45° FOV · retinal fundus photograph:
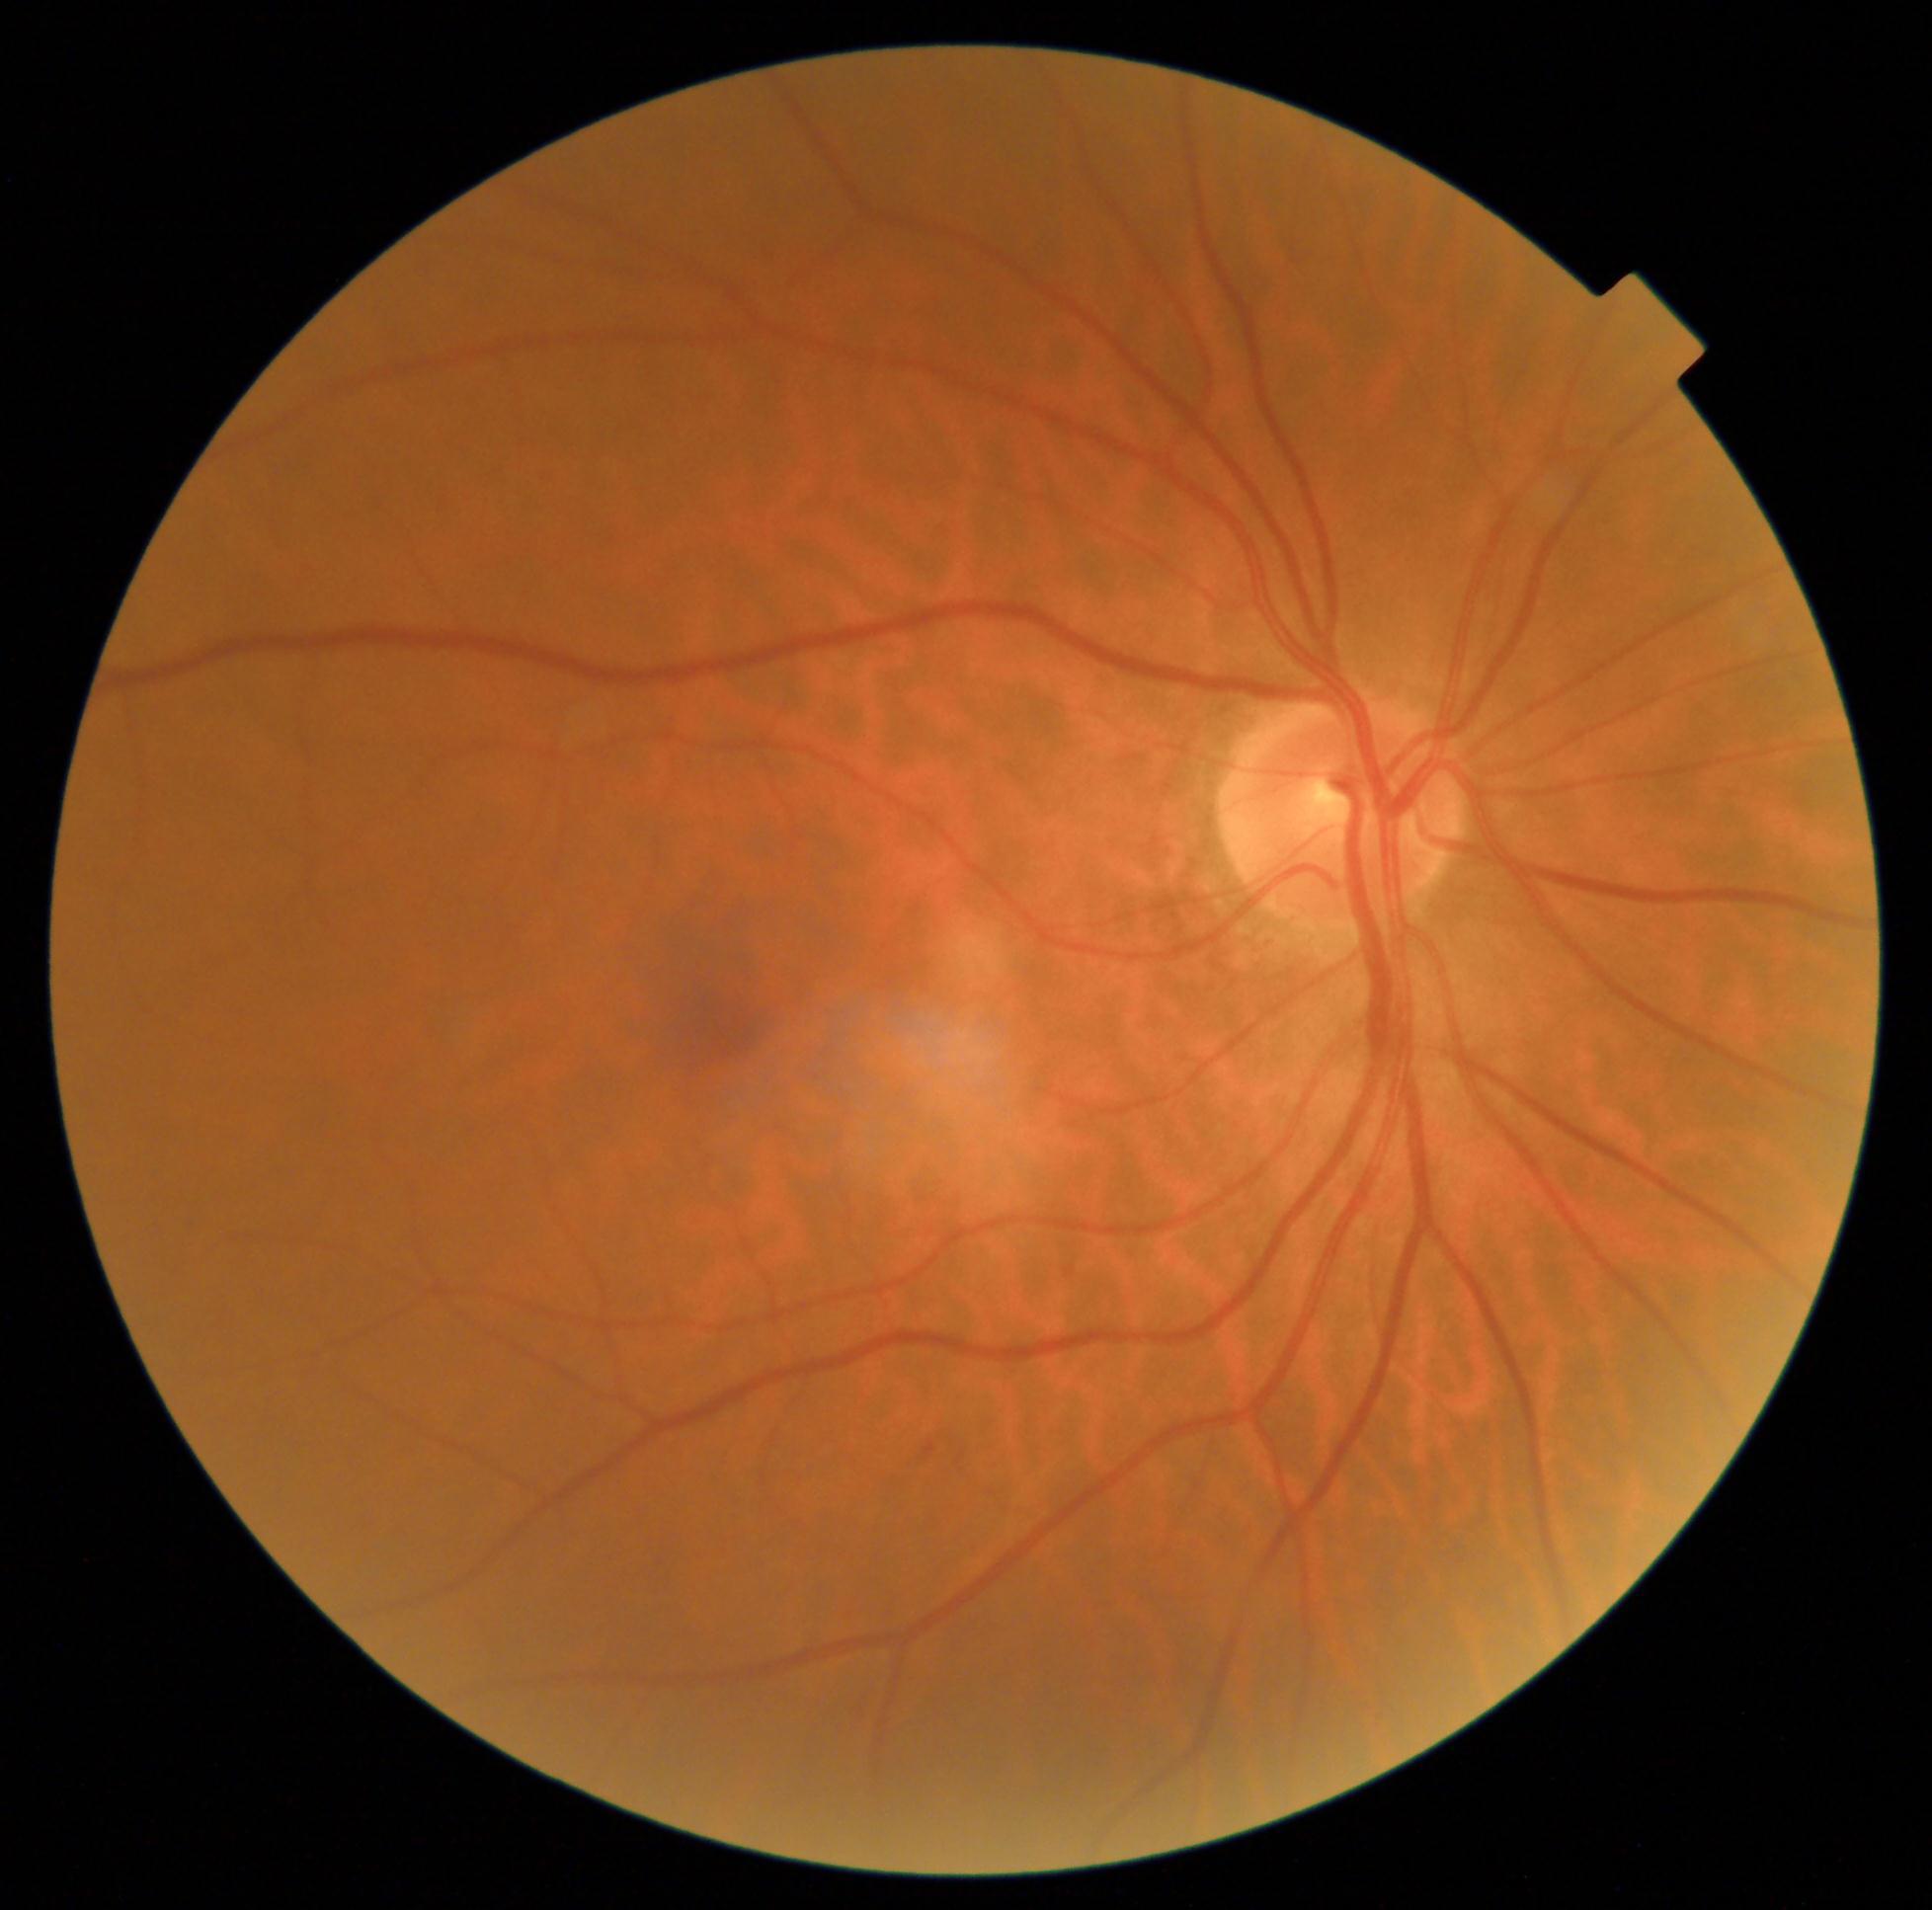 DR stage = grade 0 (no apparent retinopathy)